Captured with the Clarity RetCam 3 (130° field of view). RetCam wide-field infant fundus image.
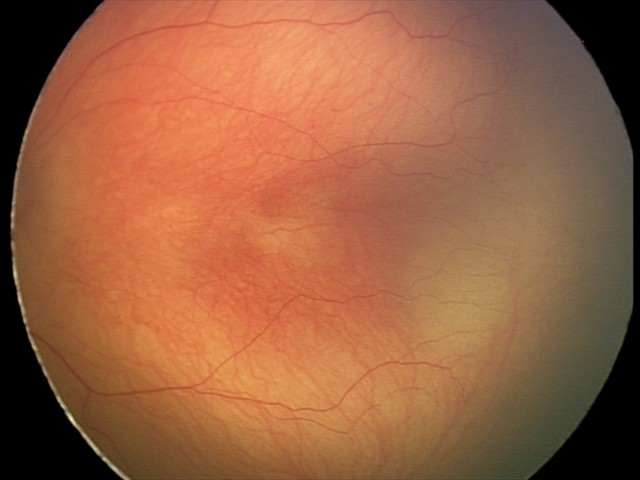
Screening: ROP stage 2 — ridge with height and width at the demarcation line.